CFP; 45° FOV
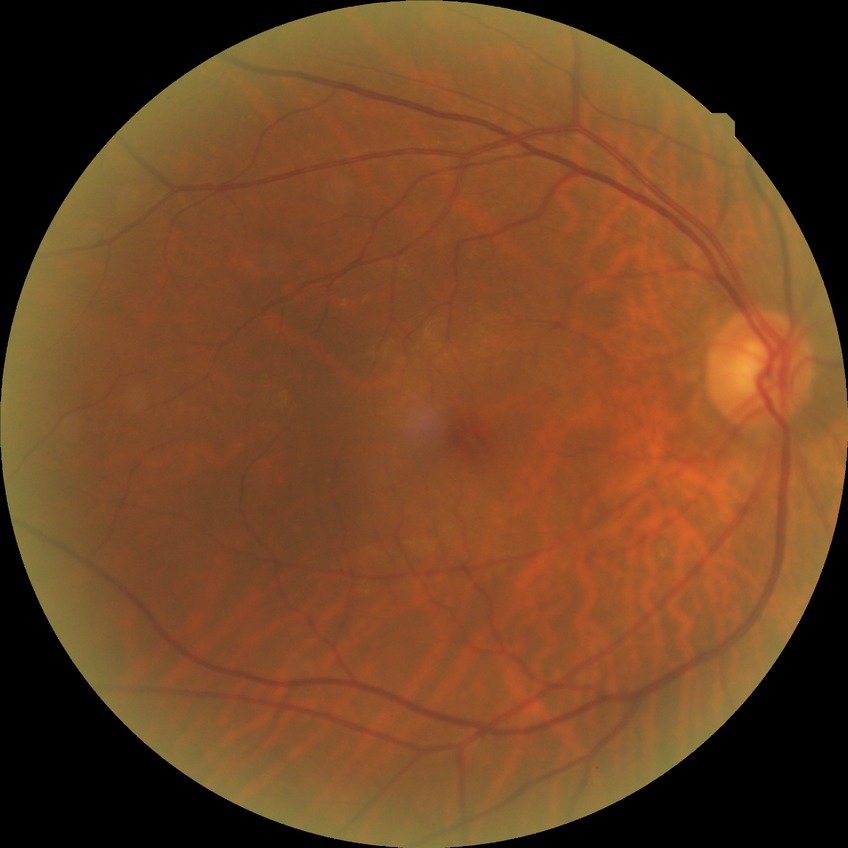

No diabetic retinal disease findings. Davis DR grade: NDR.